Wide-field fundus photograph of an infant; 1240 by 1240 pixels: 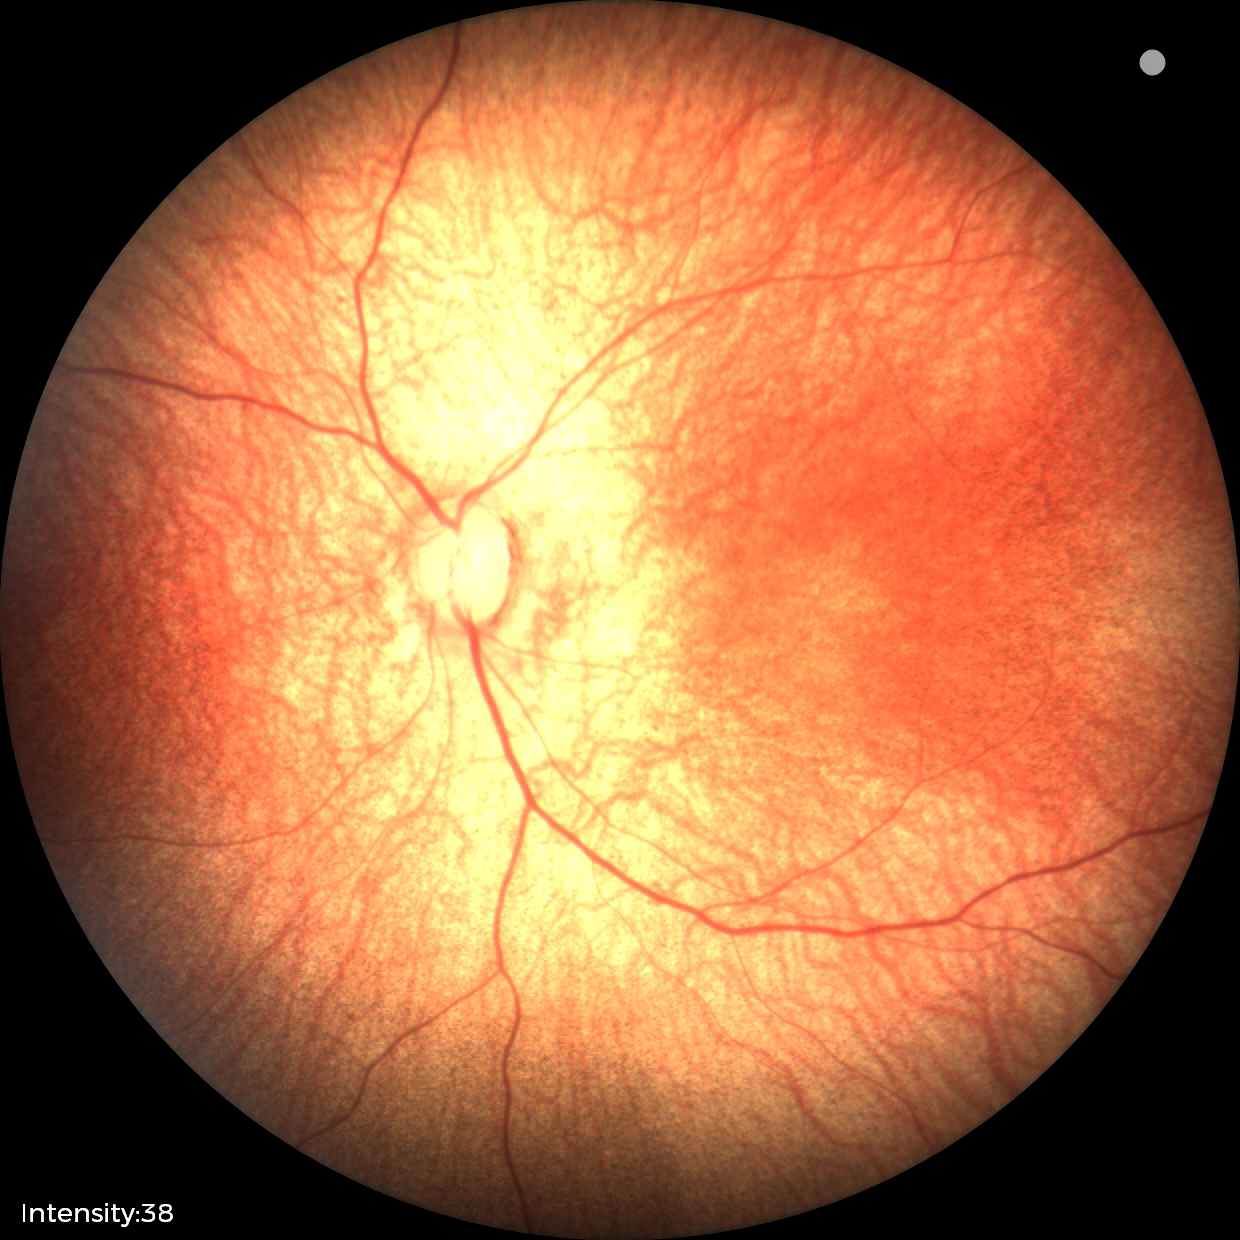

Screening examination with no abnormal retinal findings.